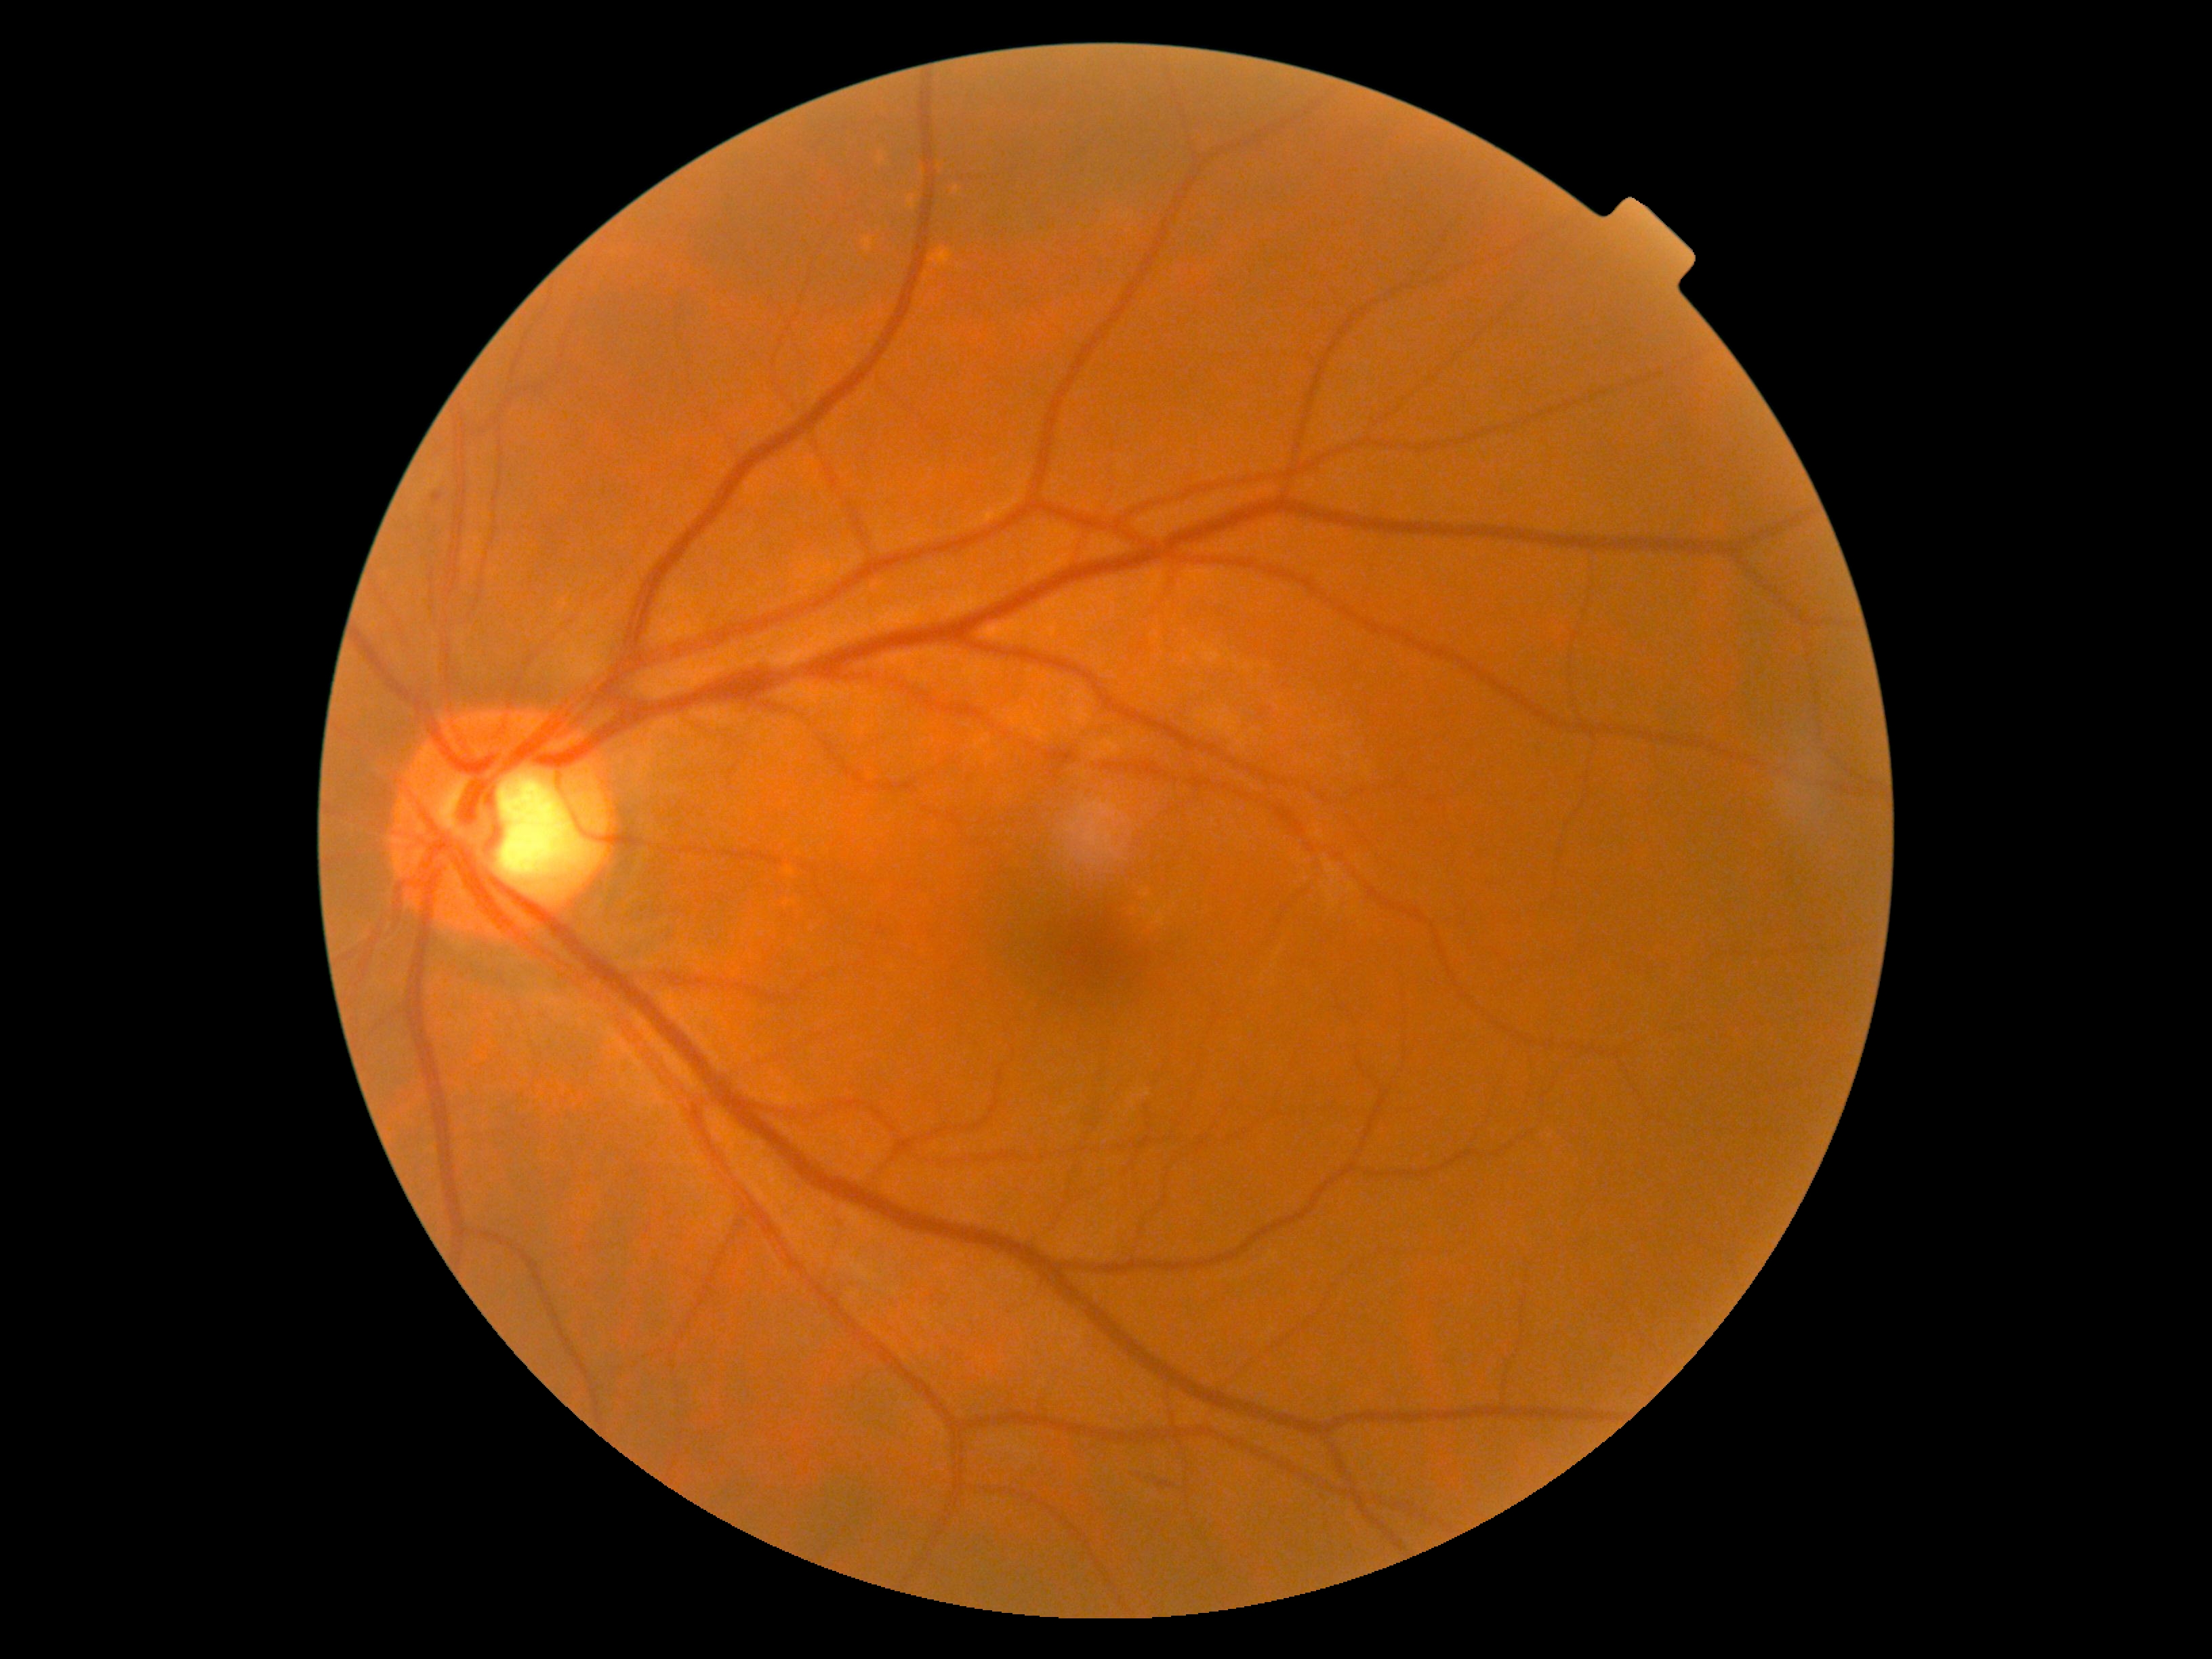

DR: grade 2.